45° FOV; fundus photo:
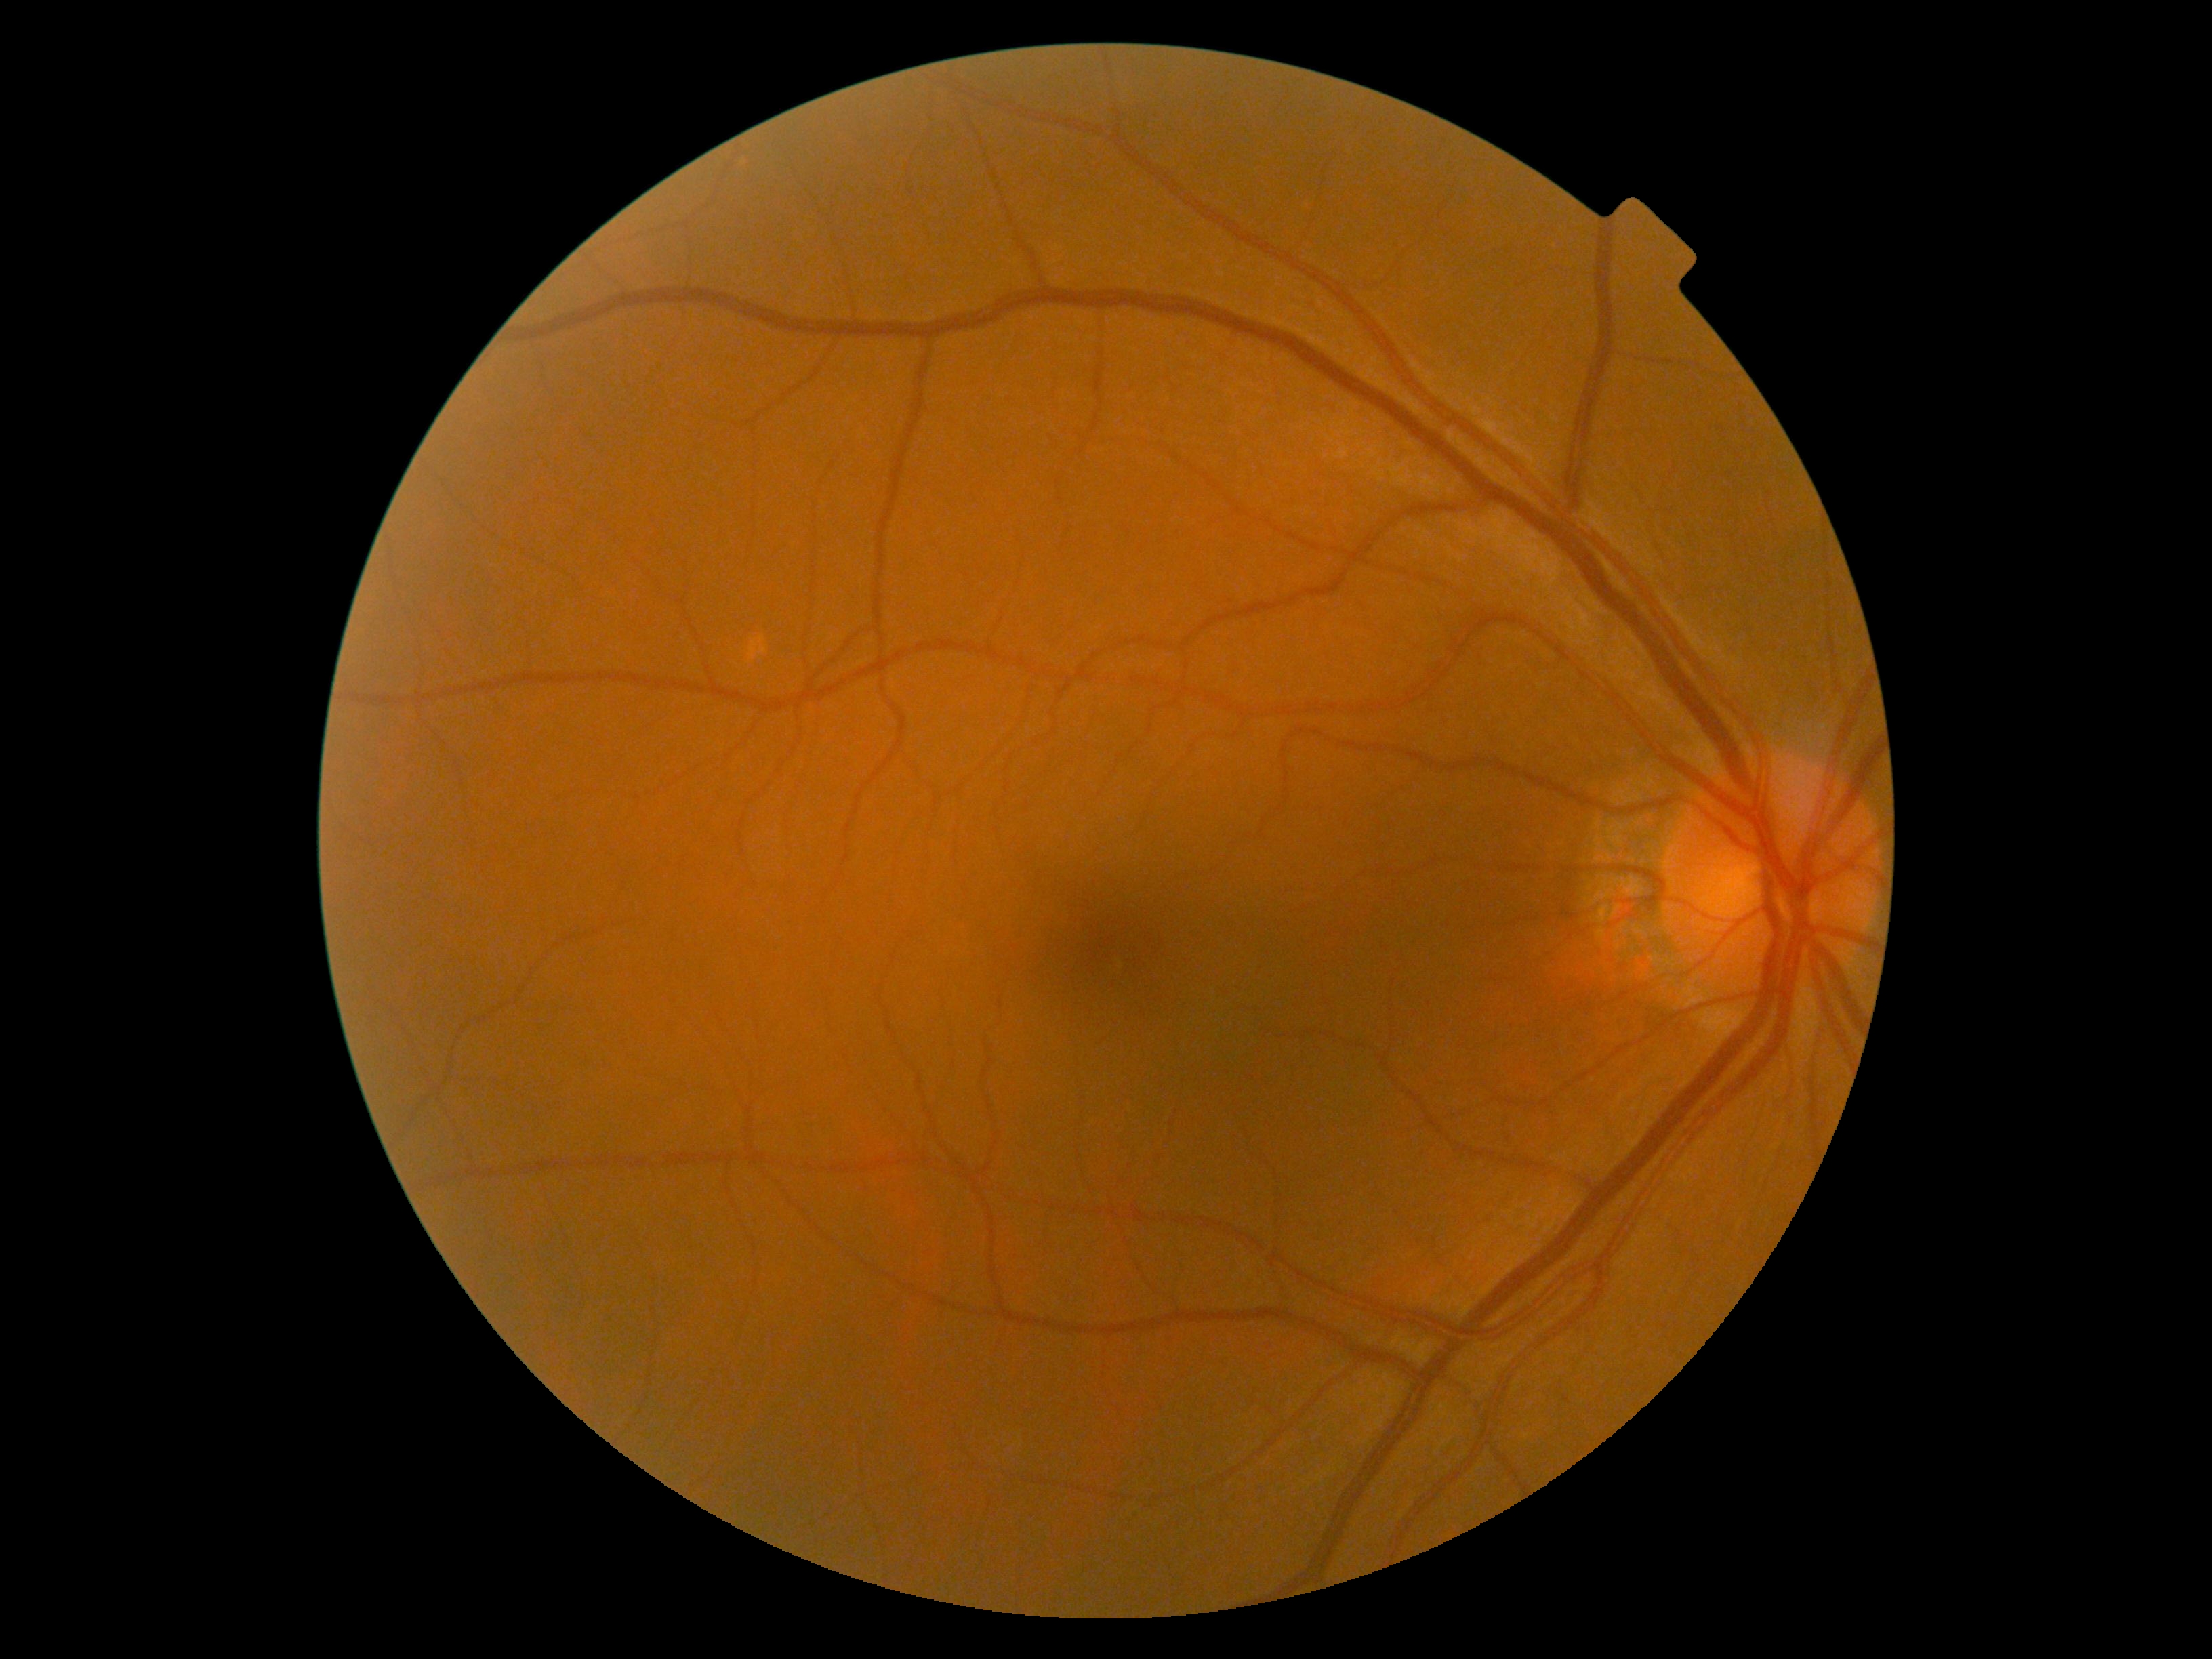
DR is no apparent retinopathy (grade 0) — no visible signs of diabetic retinopathy.